45° field of view
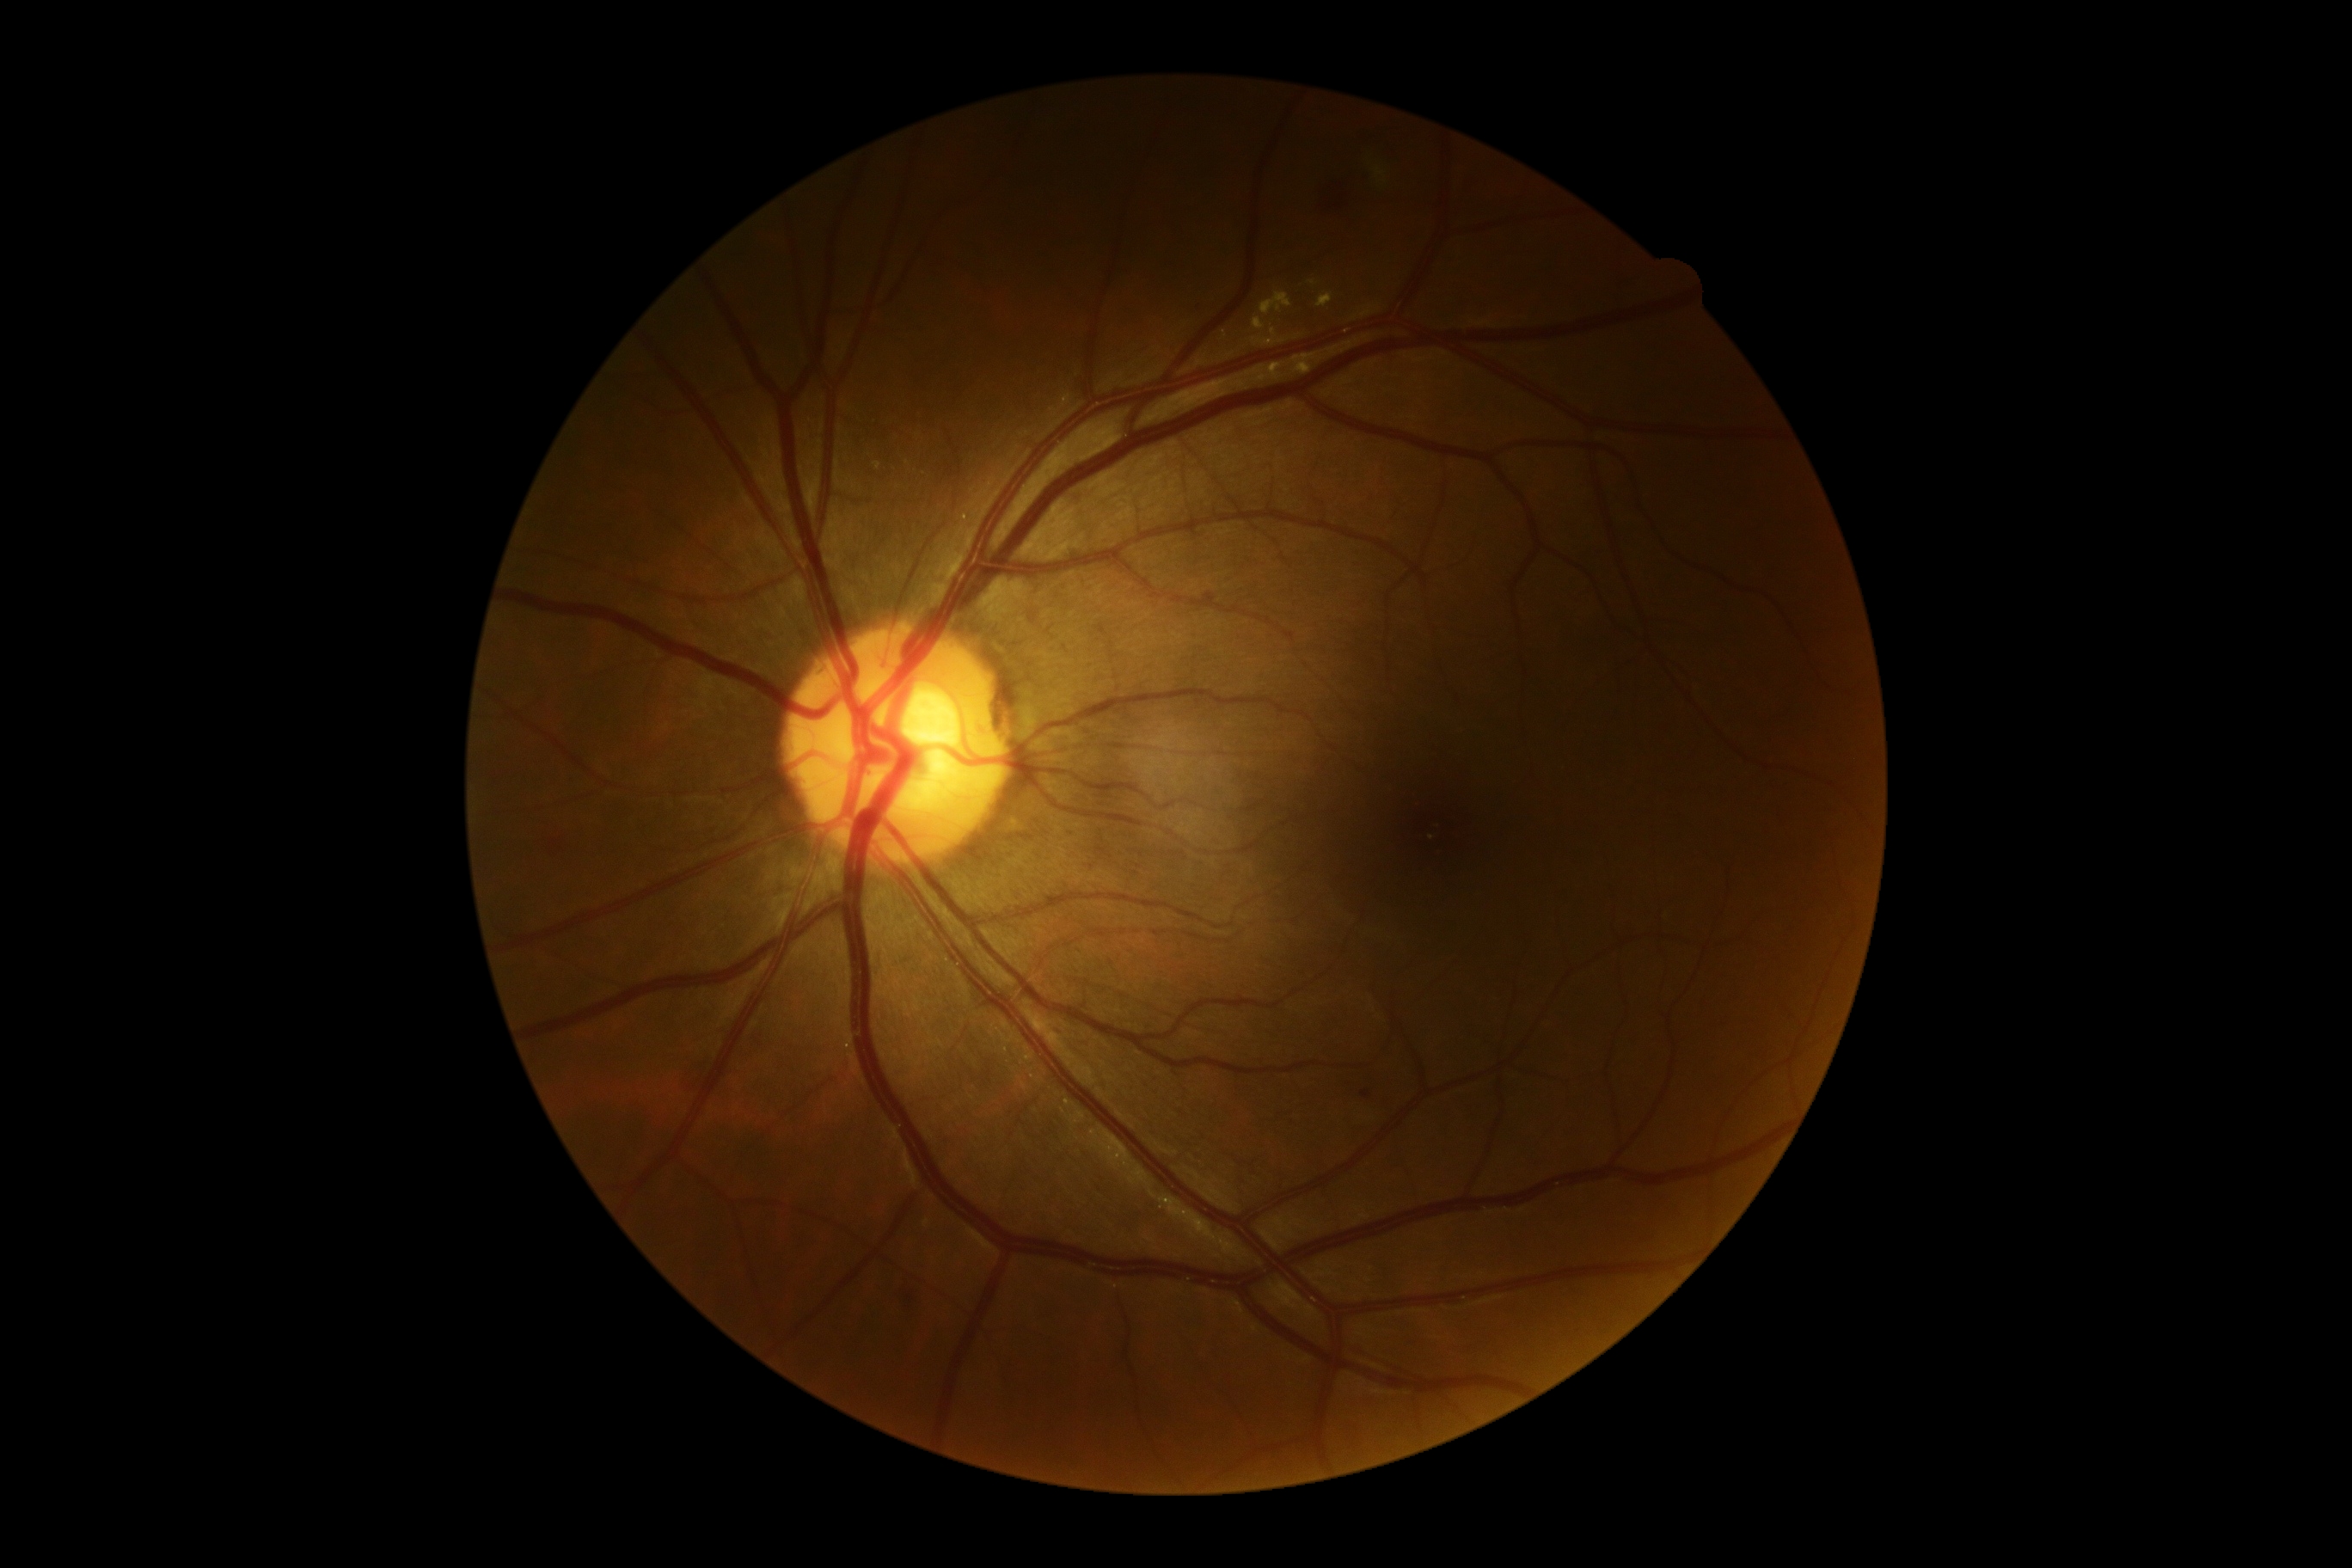
DR stage = 2/4